Retinal fundus photograph. Davis DR grading — 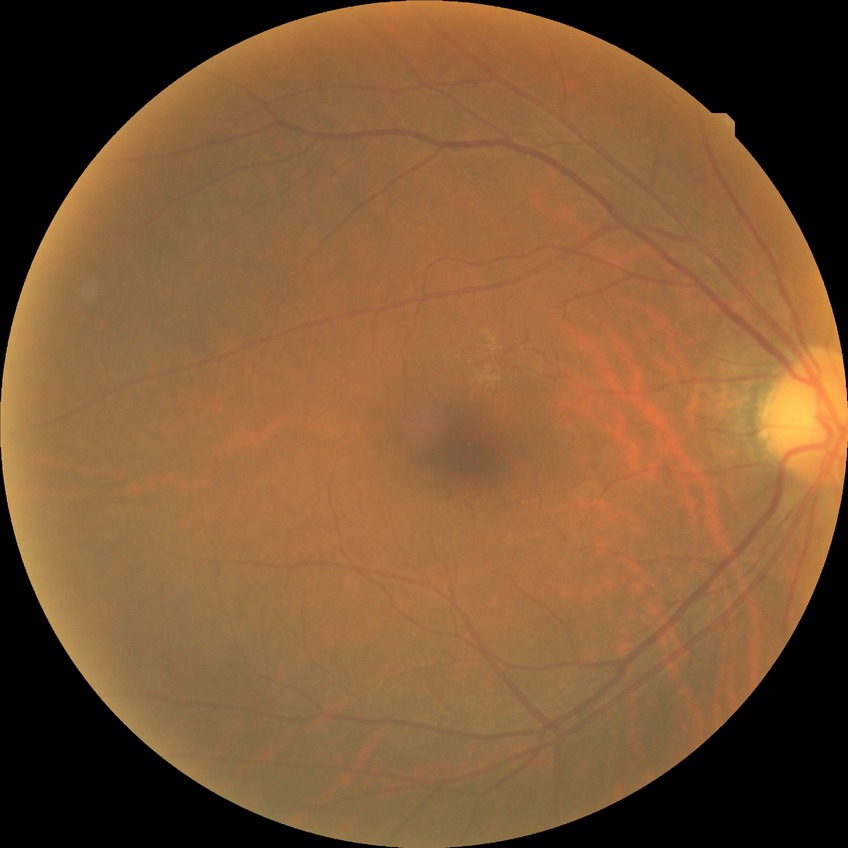

No diabetic retinal disease findings. DR severity is NDR.